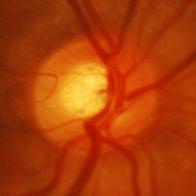

Glaucomatous optic neuropathy is present. Optic nerve head appearance consistent with glaucomatous changes.